Pediatric wide-field fundus photograph; 640 by 480 pixels — 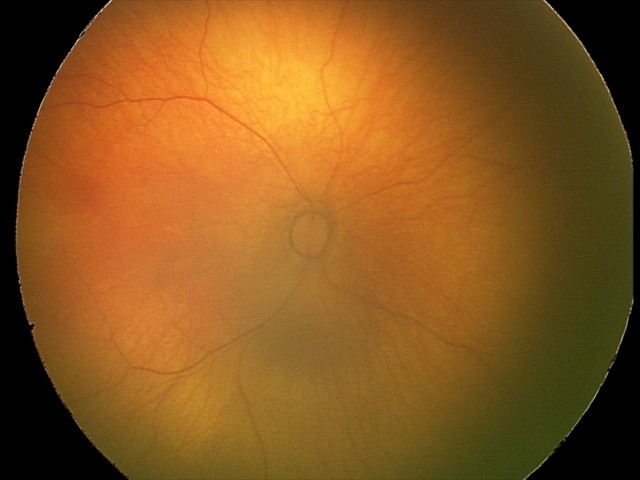
Physiological retinal appearance for postconceptual age.